Topcon TRC-50DX; dilated-pupil acquisition; 2228 x 1652 pixels: 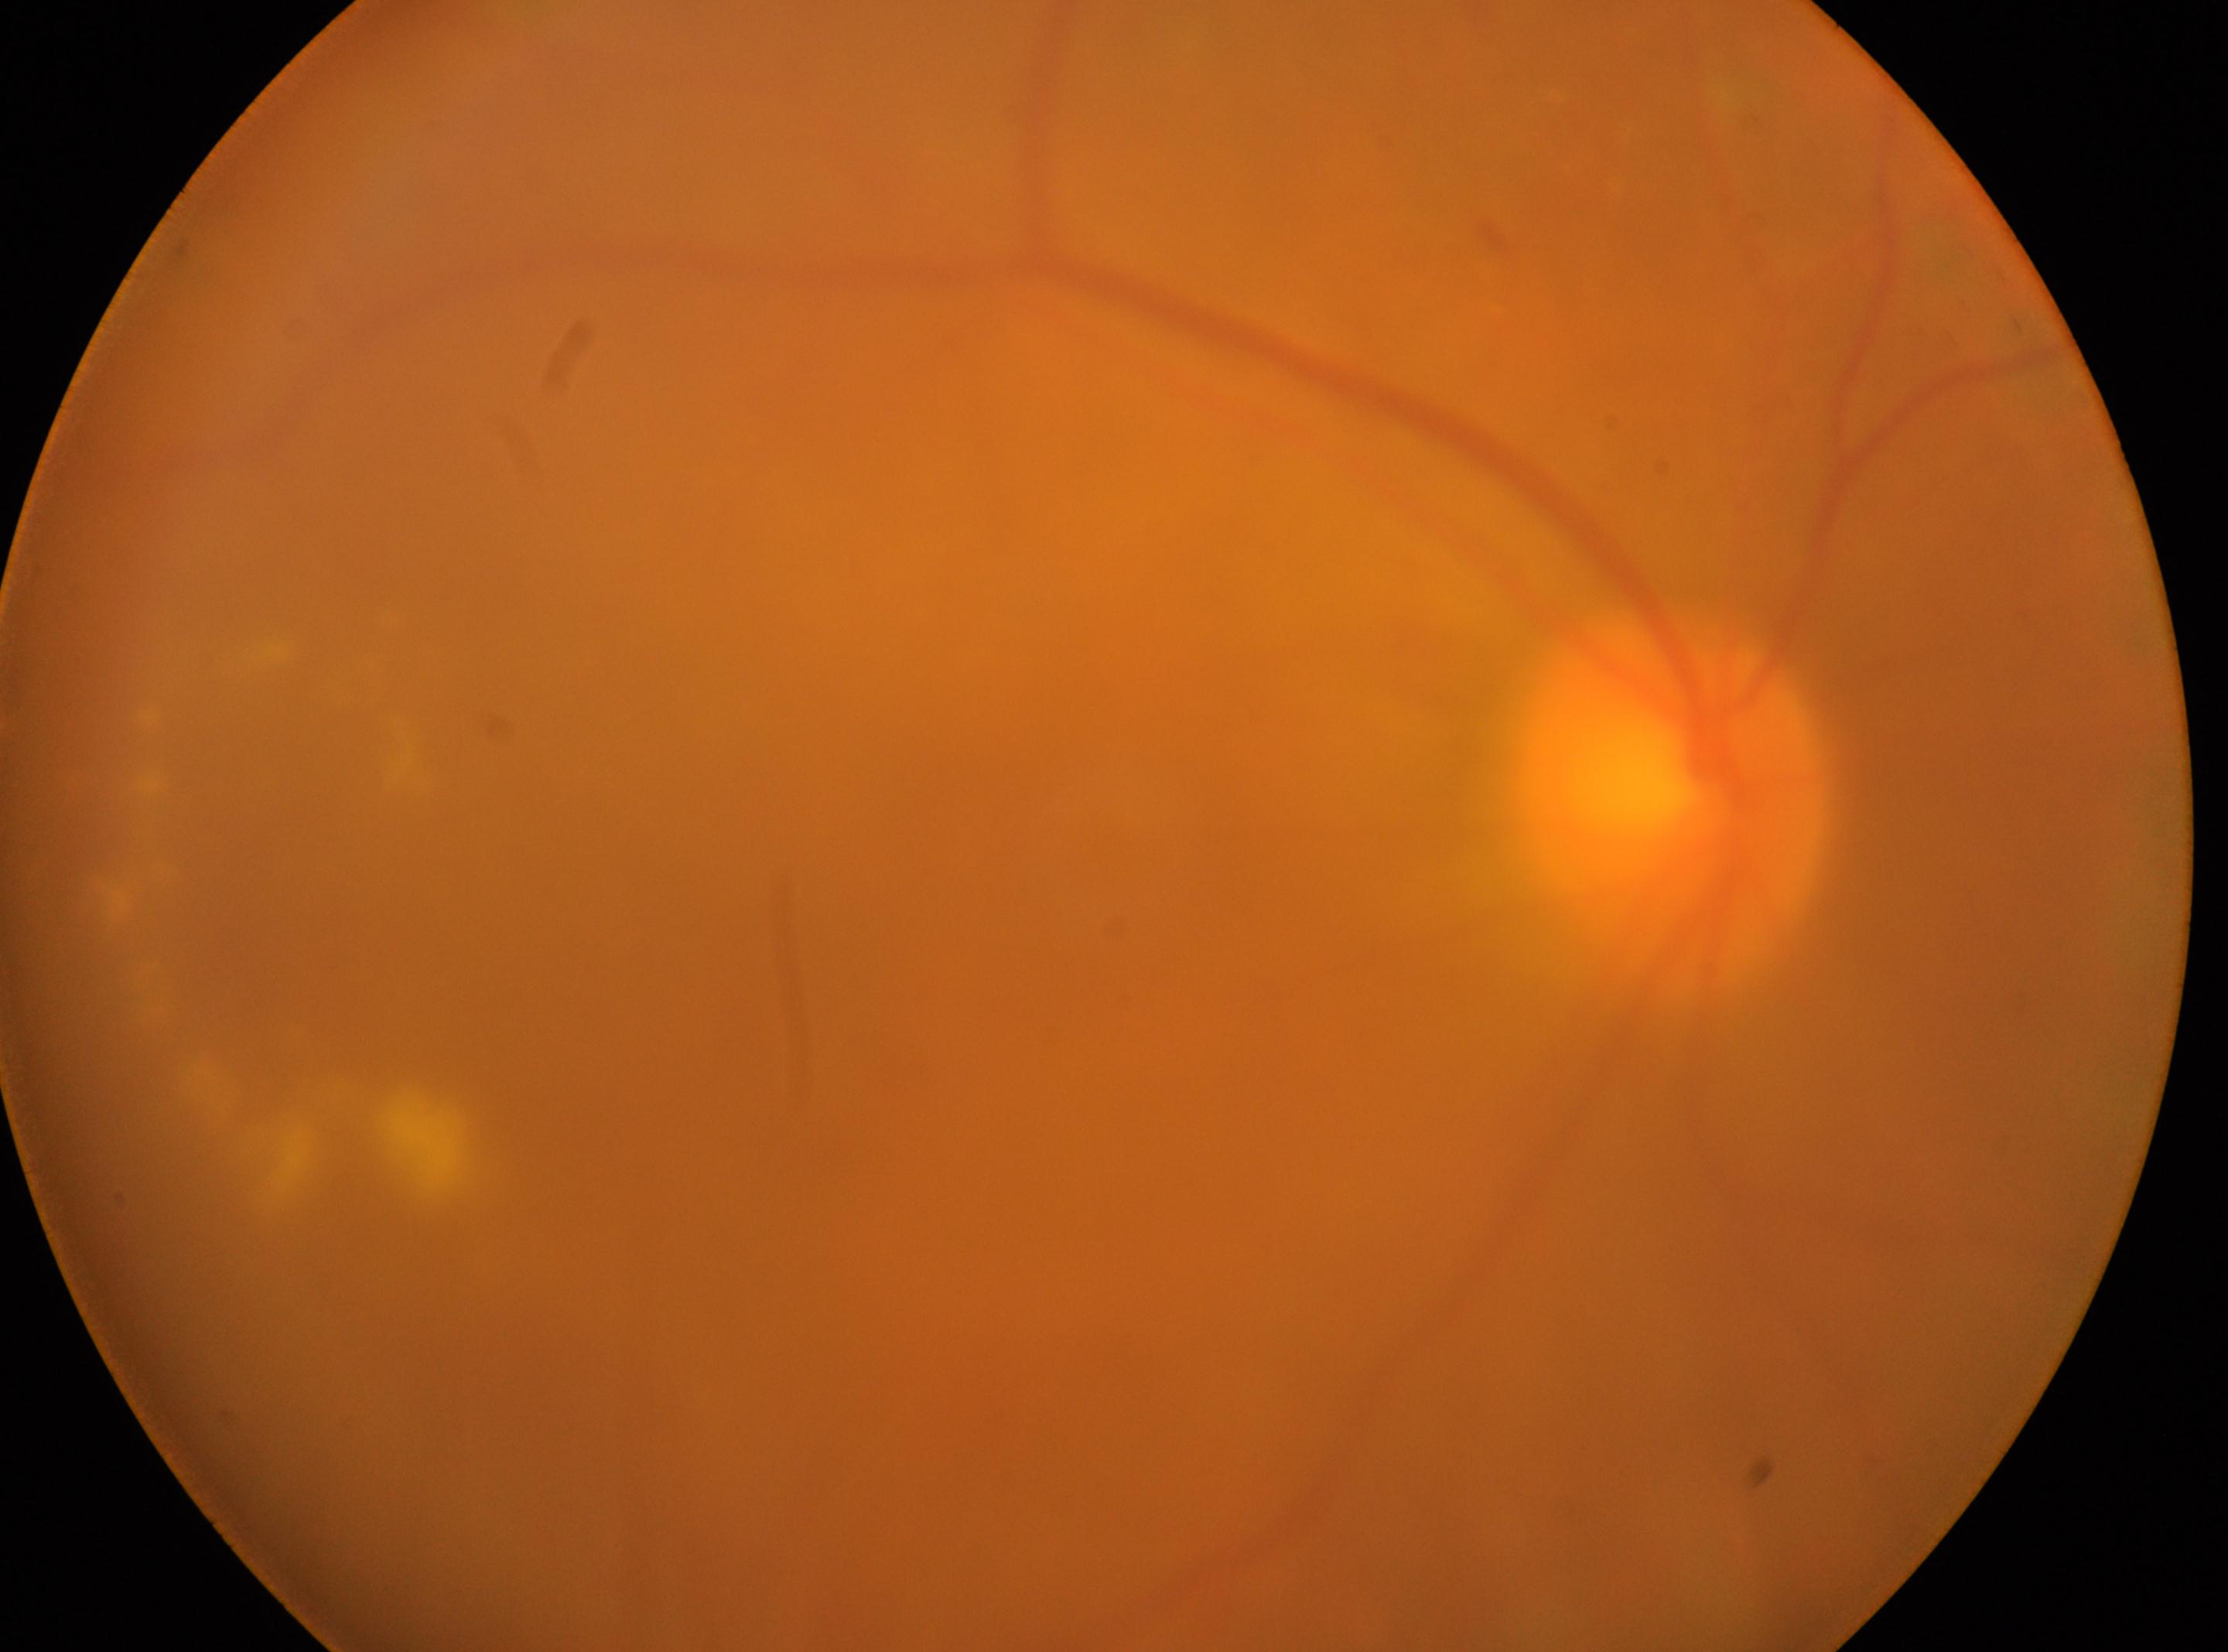

The optic disc is at (1669, 800). Eye: the right eye. DR class: non-proliferative diabetic retinopathy. Diabetic retinopathy severity is moderate non-proliferative diabetic retinopathy (grade 2). Macular center: (831, 971).